Acquired with a Nidek AFC-330 · optic disc region crop · image size 240x240: 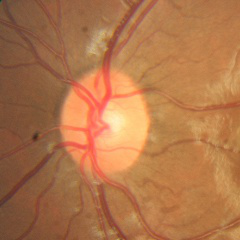
Q: Does this eye have glaucoma?
A: No glaucoma.